2089 by 1764 pixels
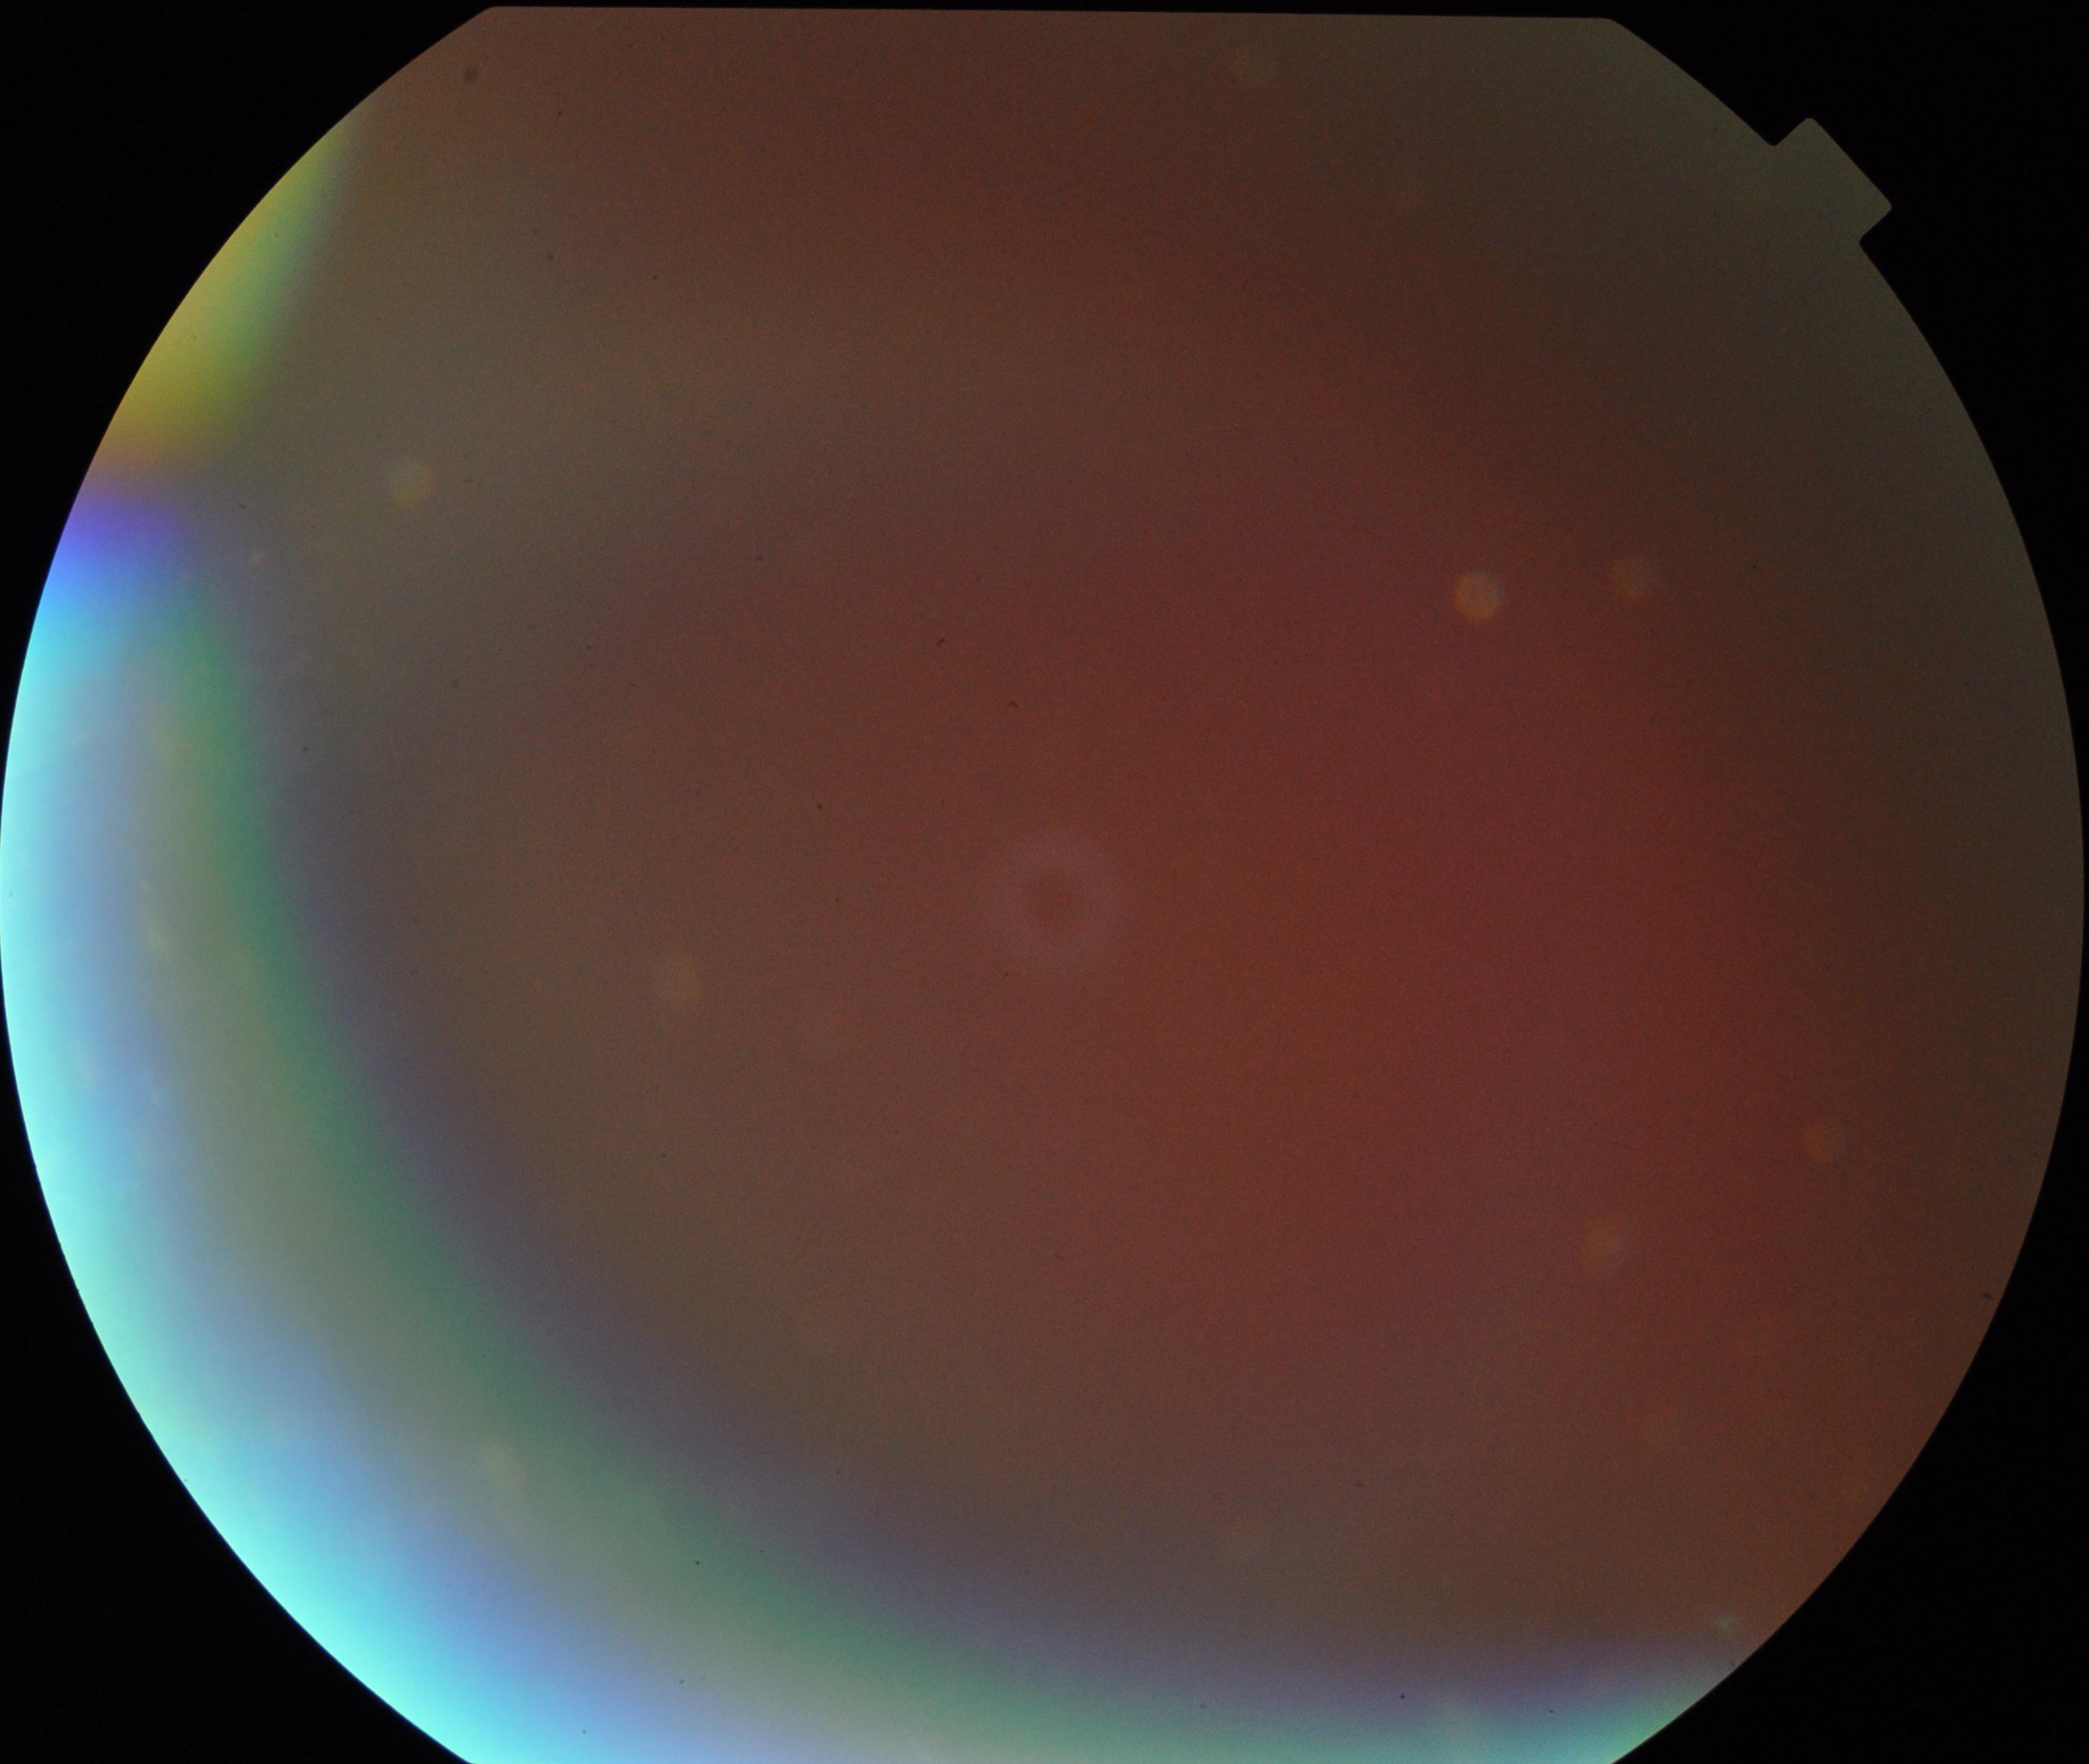
Image quality: poor.
Proliferative diabetic retinopathy: negative.